640x480. Wide-field fundus photograph from neonatal ROP screening. Captured with the Clarity RetCam 3 (130° field of view)
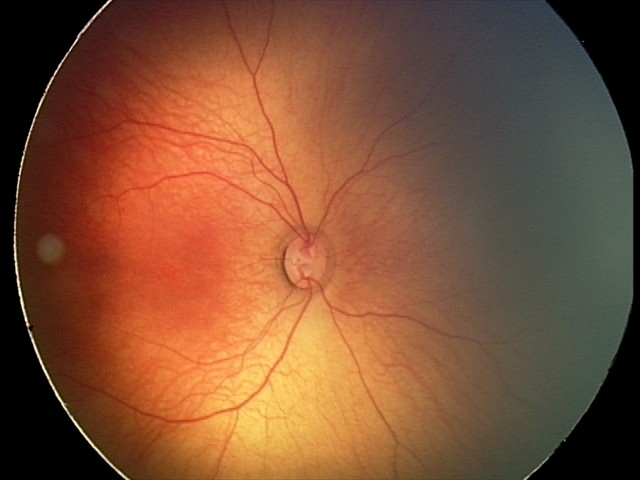

Normal screening examination.